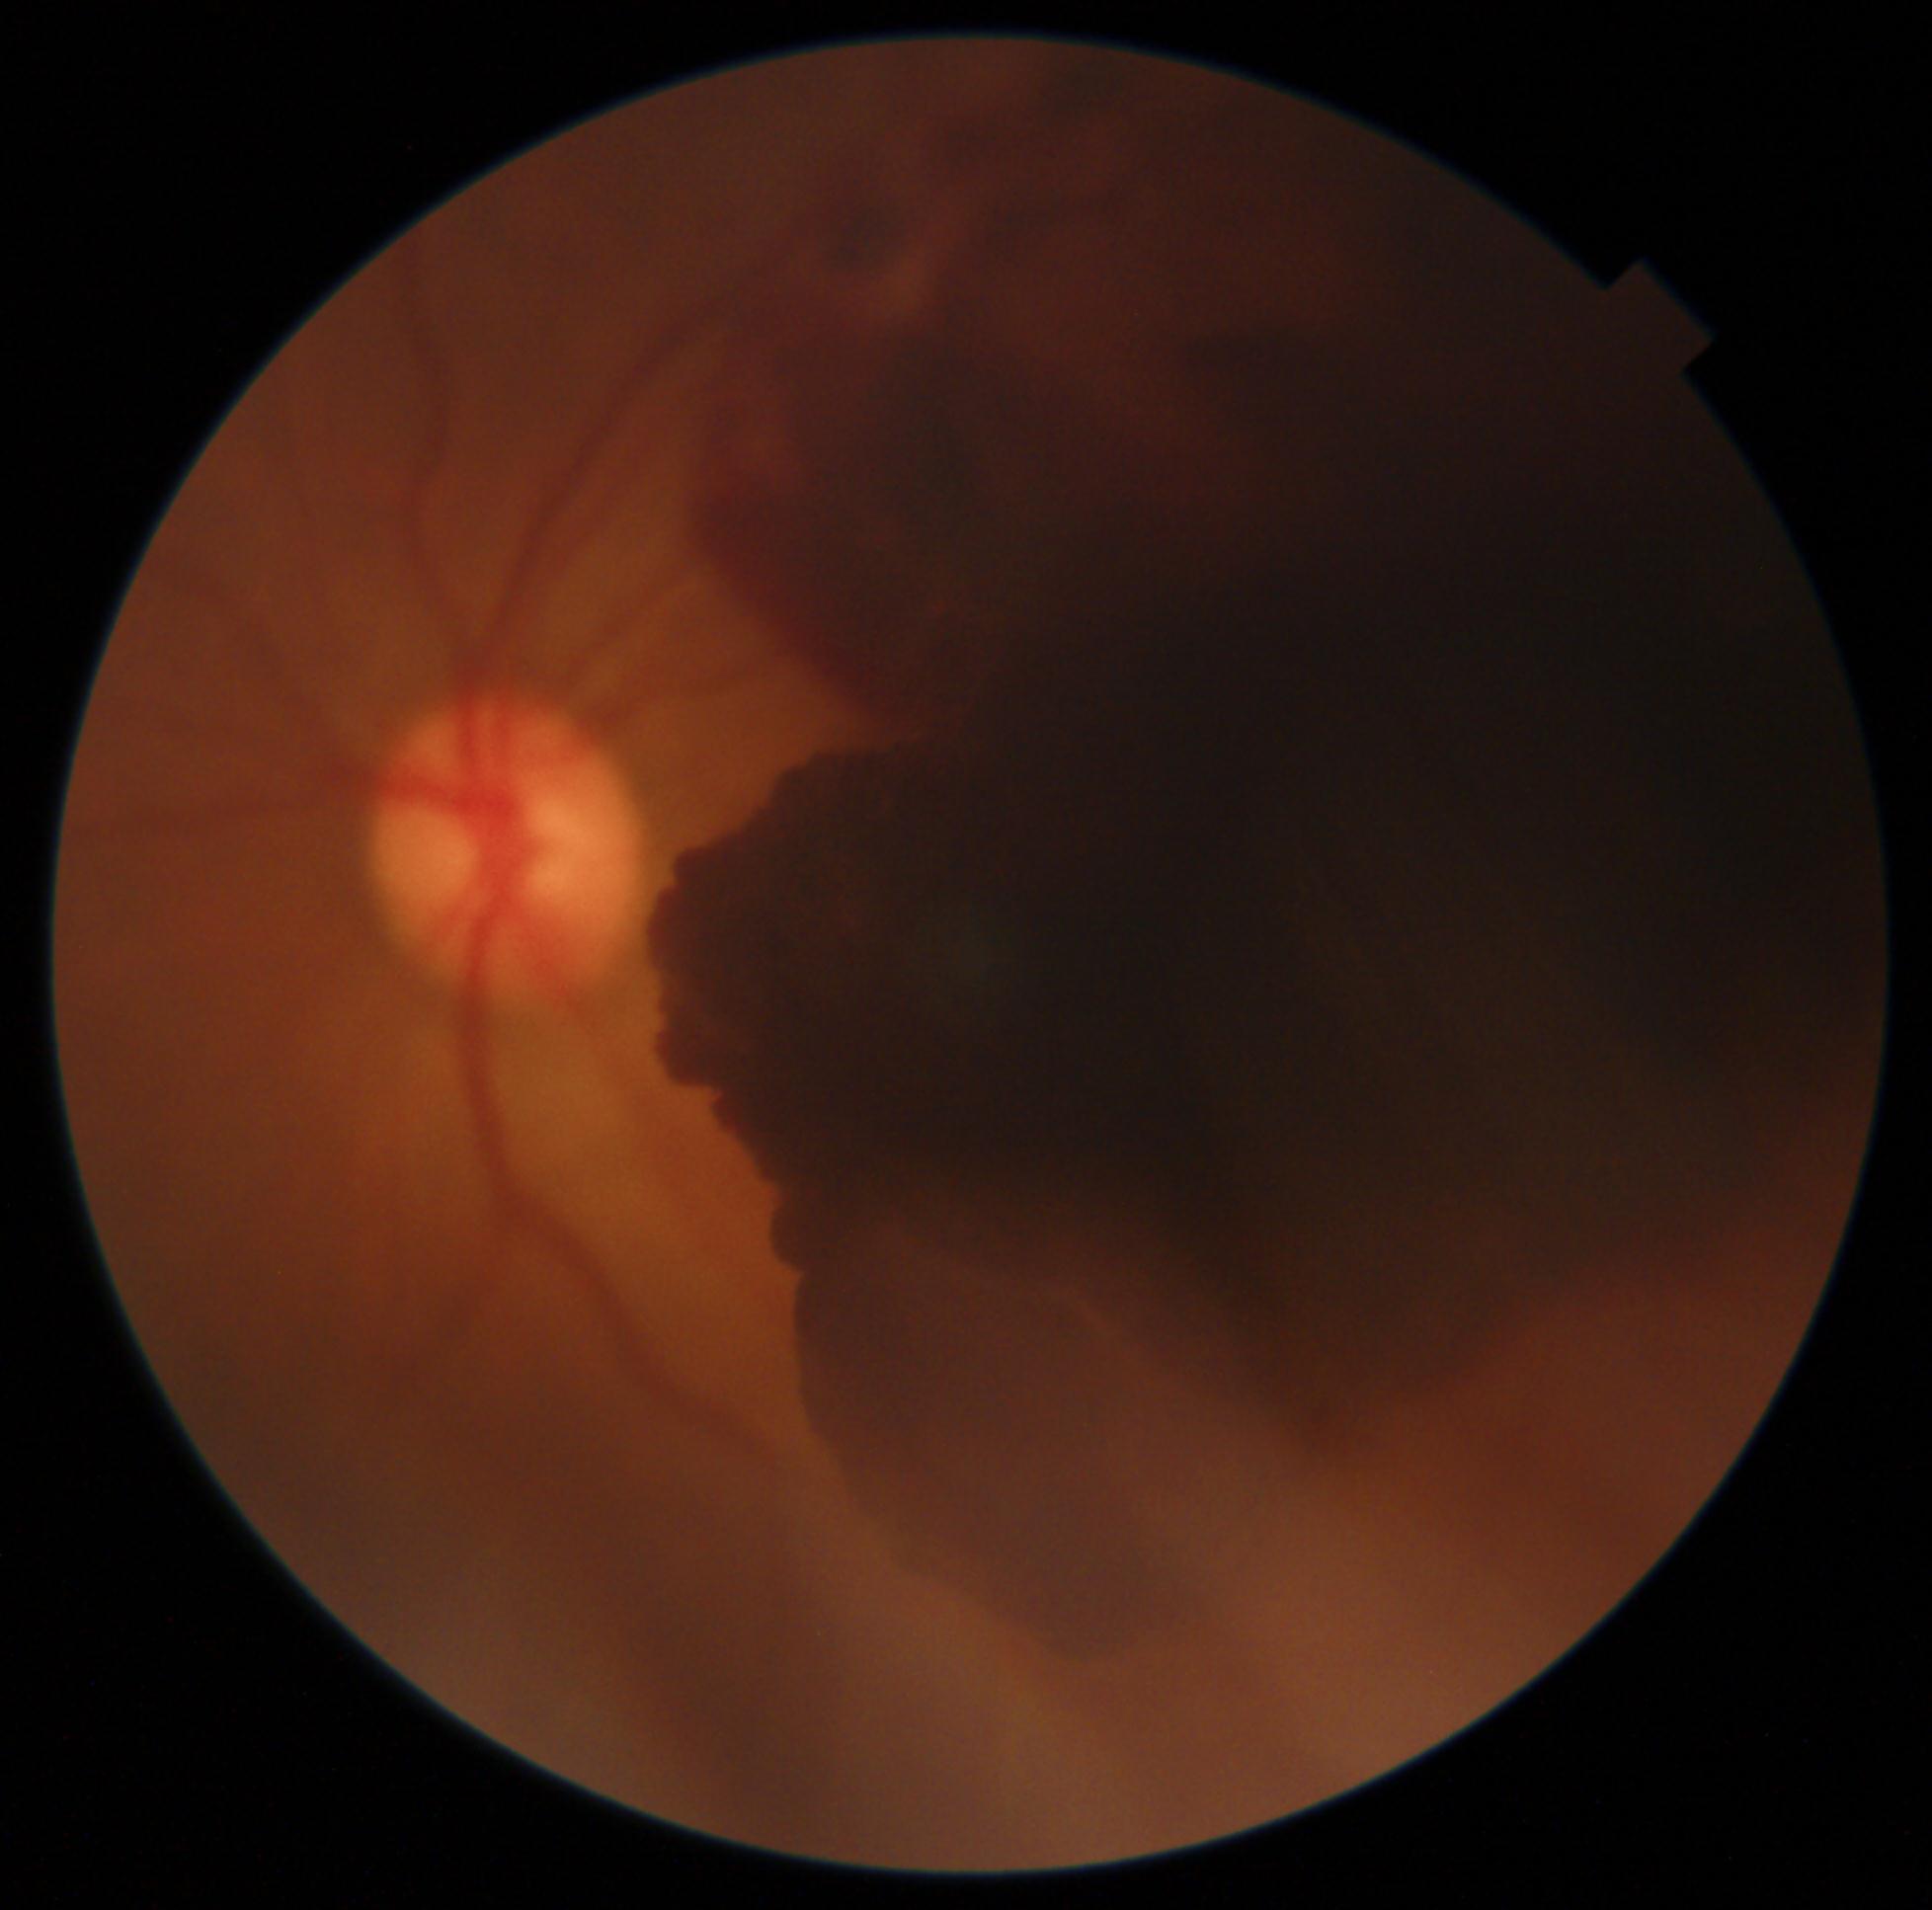

DR: grade 4 (PDR), DR class: proliferative diabetic retinopathy.